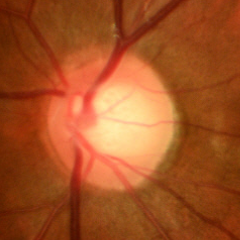 Q: Does this eye have glaucoma?
A: Early glaucomatous optic neuropathy.